FOV: 60 degrees. Handheld portable fundus camera image: 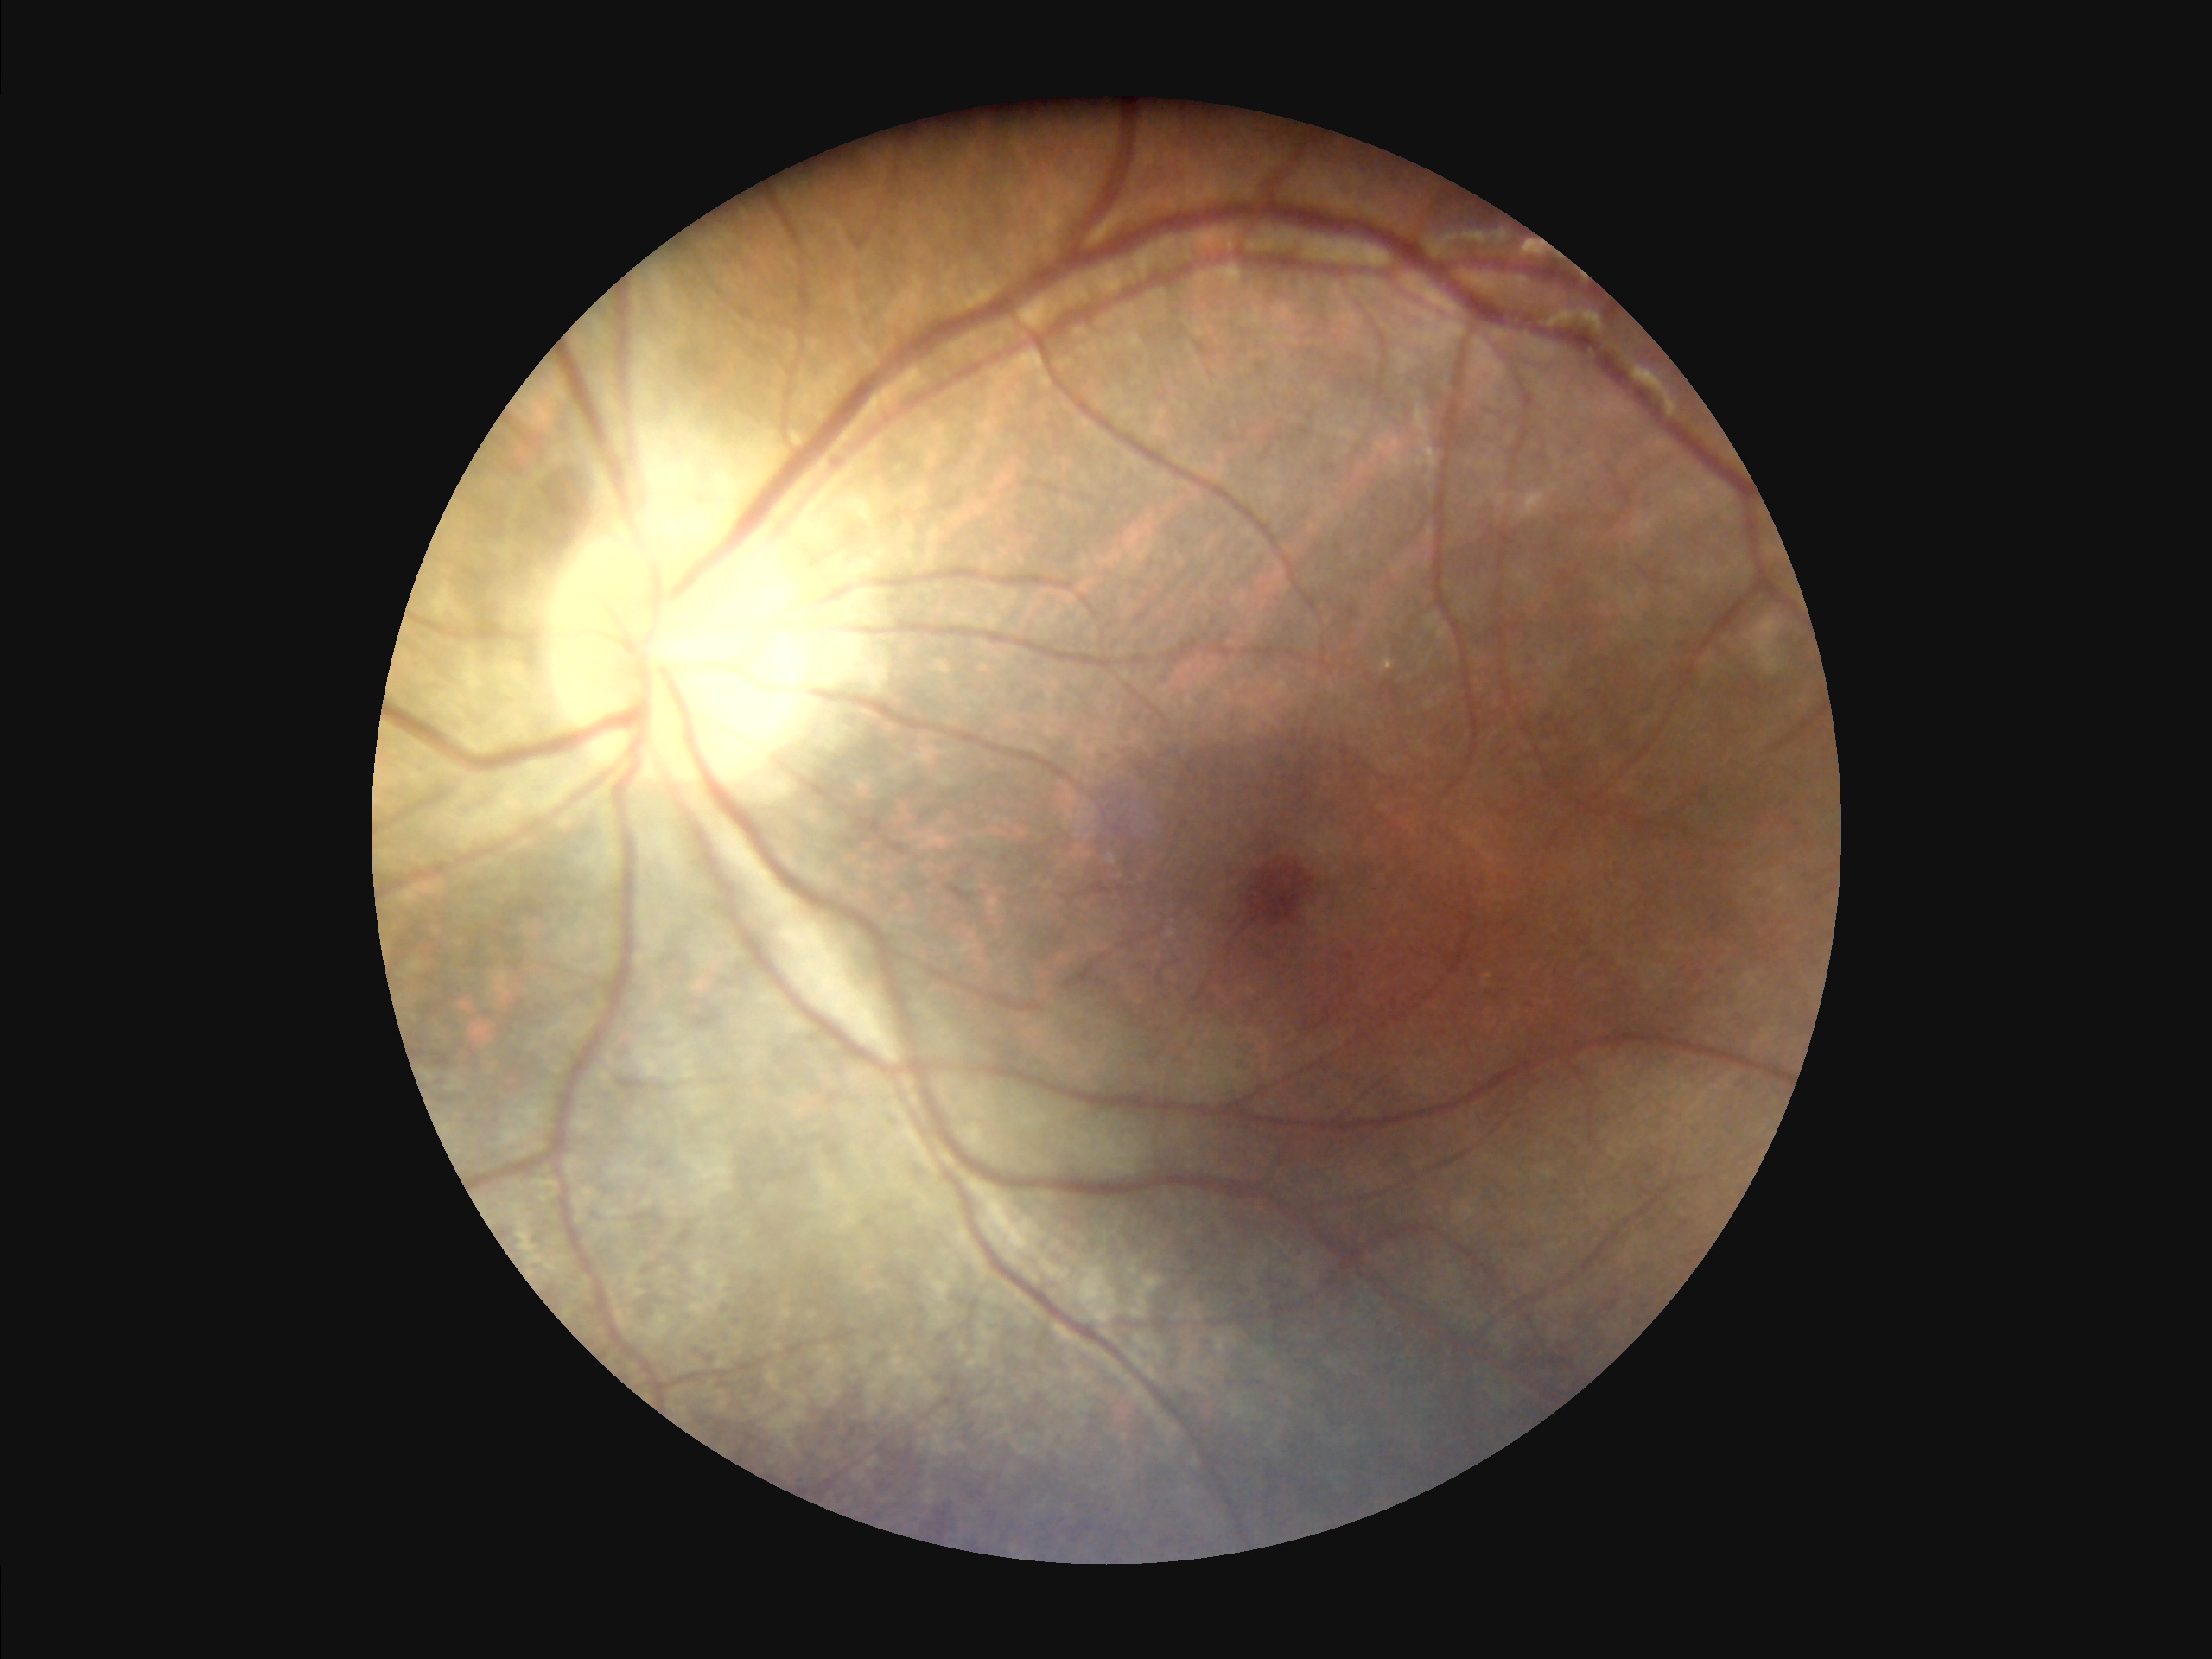

The image is clear. Overall image quality is good. There is over- or under-exposure or a color cast.